45-degree field of view. 2048x1536px — 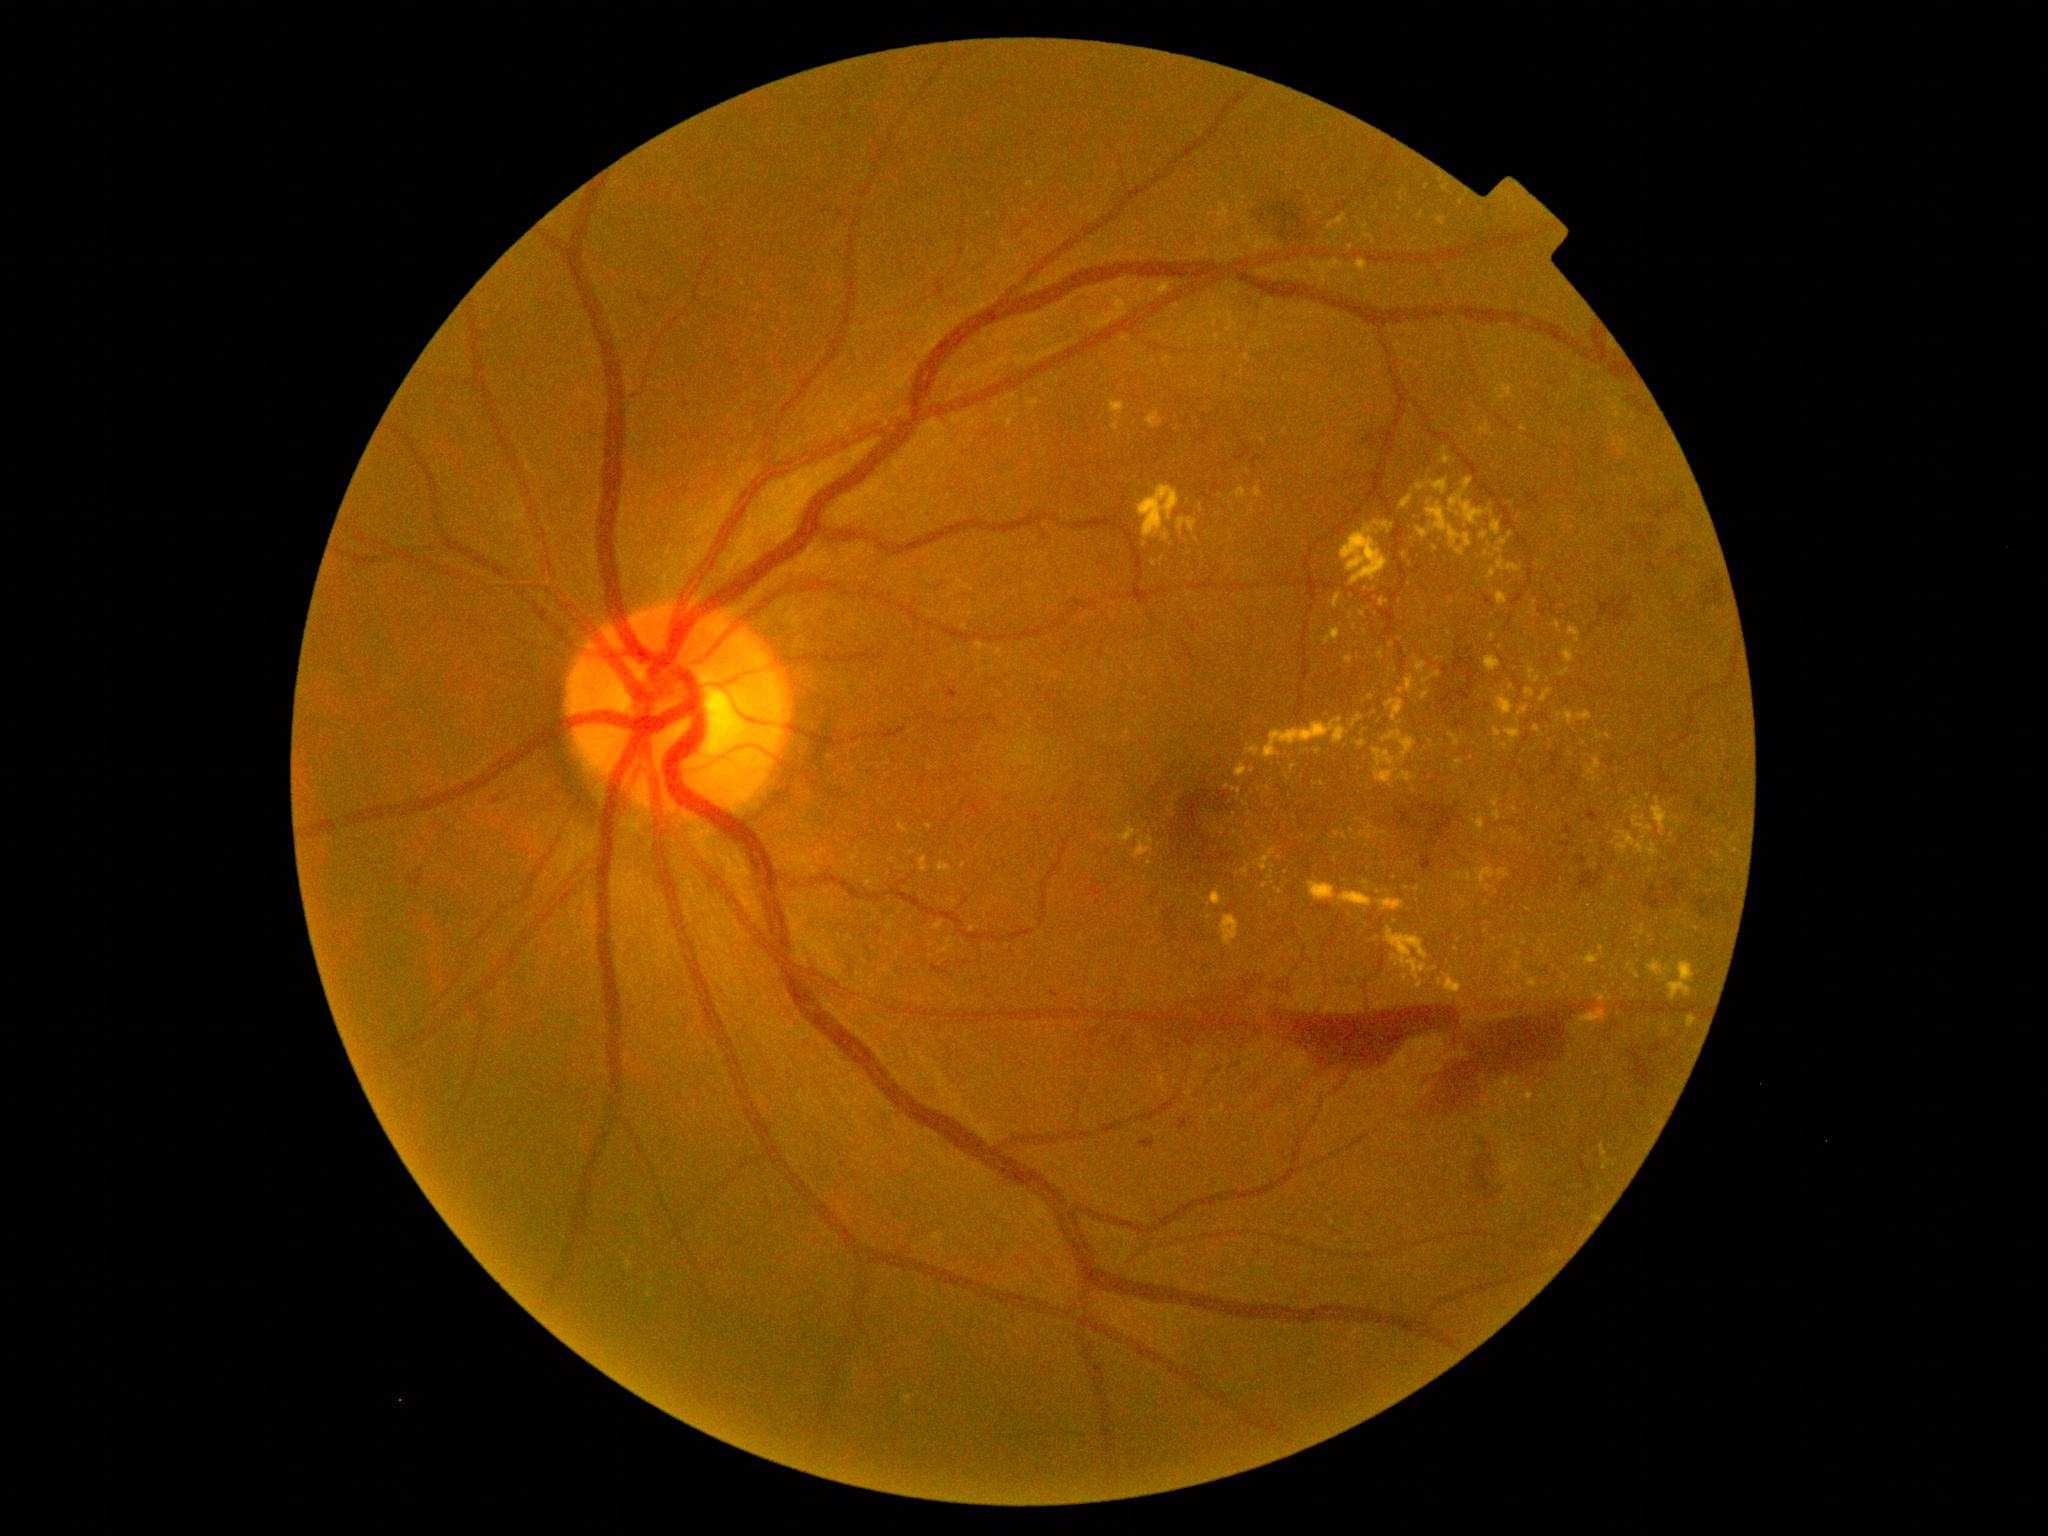
Diabetic retinopathy (DR): grade 4.
Hemorrhages (HEs) are present, including at <box>1645,886,1665,911</box>, <box>1579,866,1605,892</box>, <box>1398,806,1453,868</box>, <box>1666,894,1678,905</box>, <box>1631,1045,1666,1093</box>, <box>1444,654,1480,727</box>, <box>1673,547,1688,561</box>, <box>1662,886,1671,893</box>, <box>1364,429,1387,448</box>, <box>1268,1007,1463,1074</box>, <box>1576,855,1588,865</box>, <box>1633,524,1659,547</box>, <box>407,869,426,889</box>, <box>1665,876,1685,896</box>, <box>1526,494,1540,505</box>.
Hard exudates (EXs) are present, including at <box>939,863,951,871</box>, <box>1439,979,1443,987</box>, <box>1652,806,1668,835</box>, <box>900,825,909,833</box>, <box>1358,740,1367,747</box>, <box>1499,540,1507,546</box>, <box>1264,719,1348,759</box>, <box>1449,733,1460,747</box>, <box>1146,412,1163,430</box>, <box>1589,759,1602,776</box>, <box>1237,765,1248,776</box>.
Small EXs near [1247, 358], [1351, 247], [1379, 893], [1492, 636], [1535, 602], [1538, 680], [1697, 930], [1370, 827].